Acquired on the Phoenix ICON; infant wide-field fundus photograph.
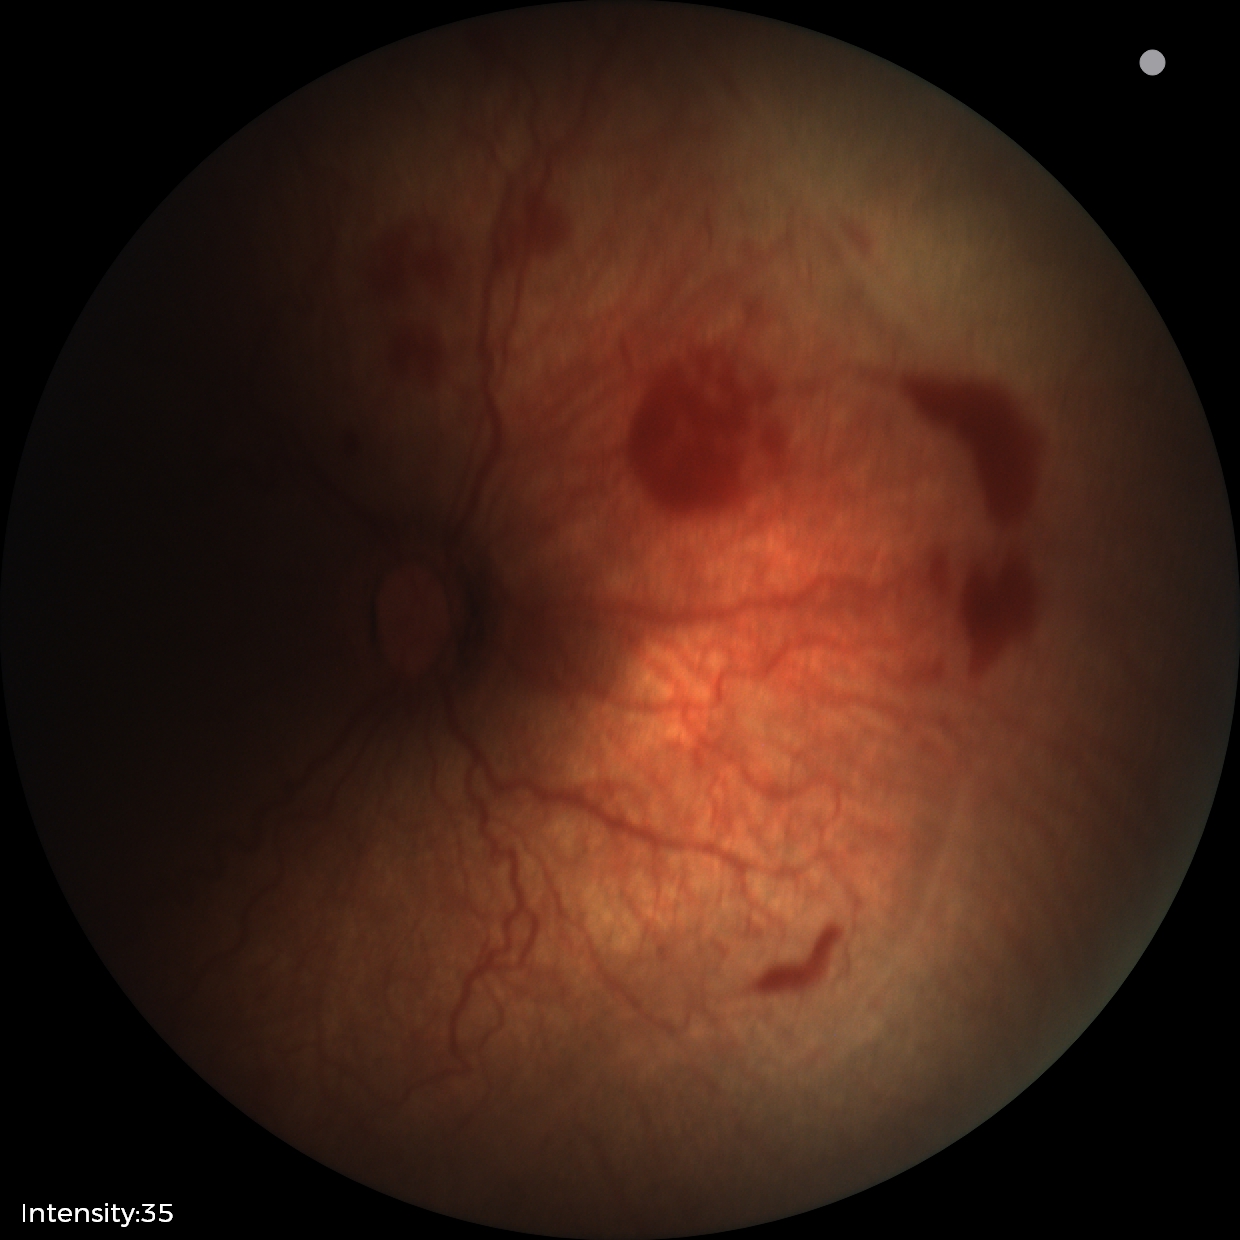
Screening series with ROP stage 2 — ridge with height and width at the demarcation line. With plus disease.